45° FOV, 2352 by 1568 pixels — 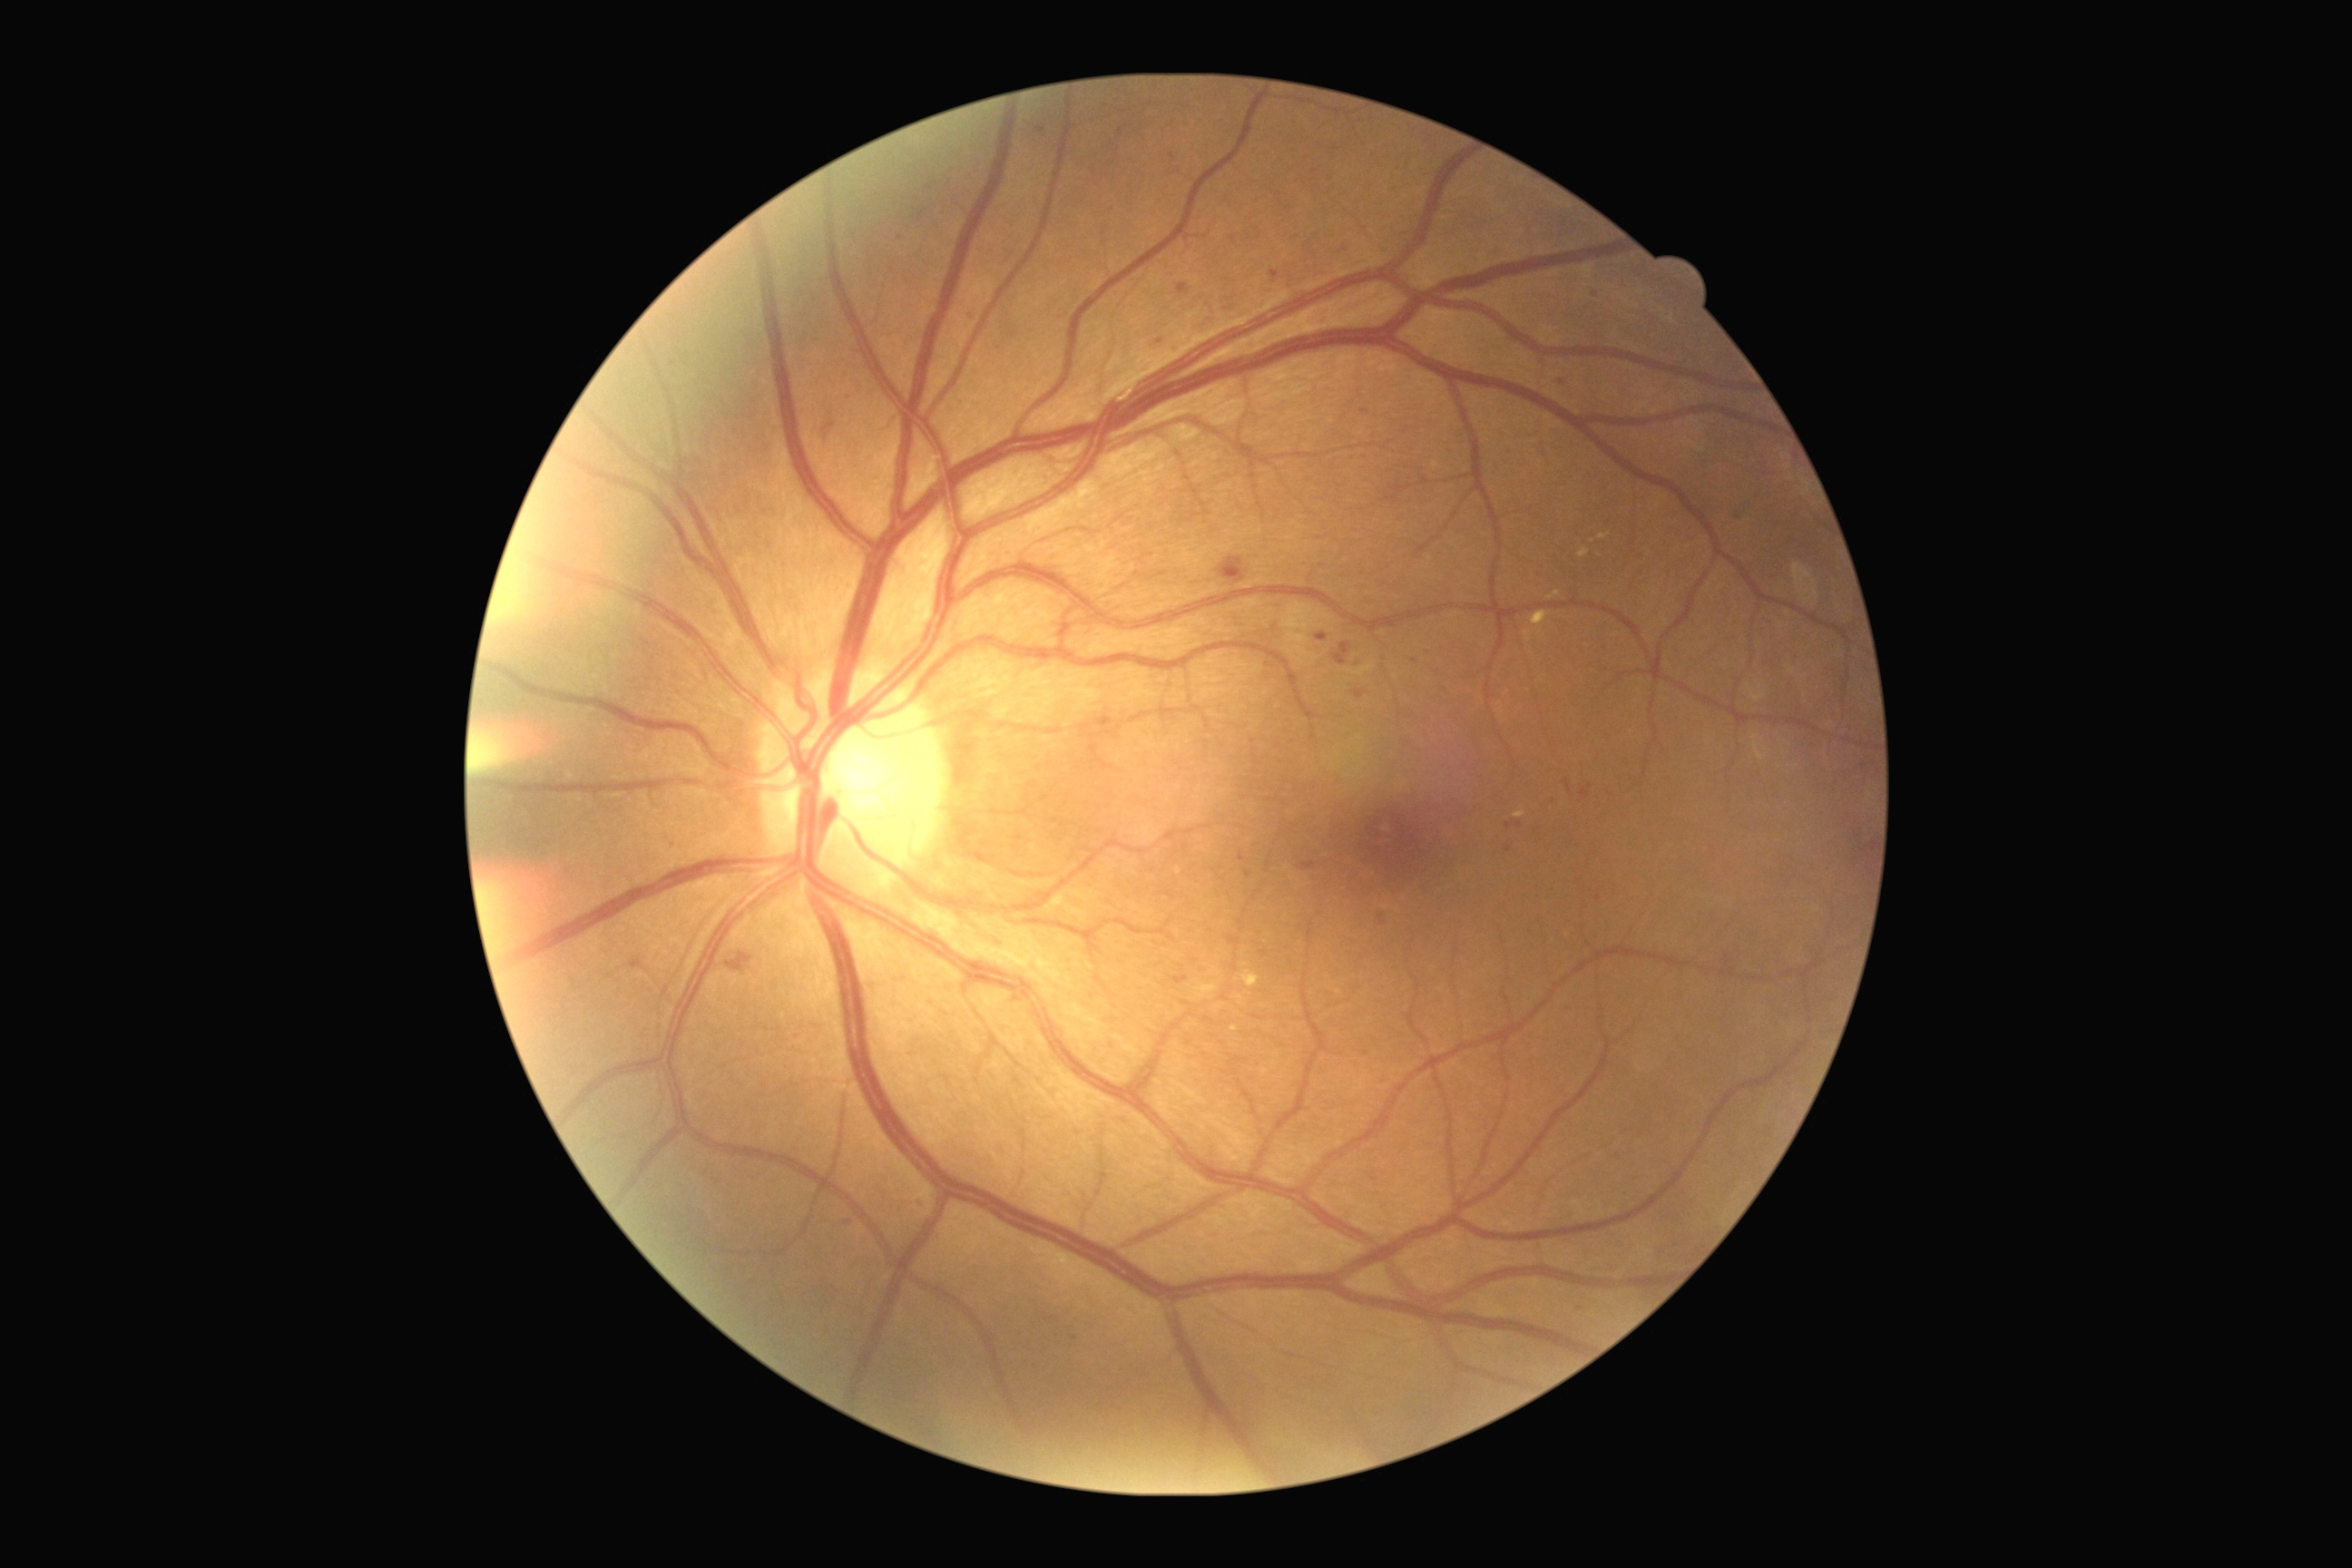

<lesions partial="true">
  <dr_grade>2</dr_grade>
  <ma partial="true">[1175,977,1188,985] | [631,957,642,970] | [1271,271,1279,279] | [1300,861,1317,872]</ma>
  <ma_small>[x=1162, y=574] | [x=922, y=214] | [x=1599, y=899] | [x=1508, y=826] | [x=1242, y=858] | [x=1248, y=876] | [x=1415, y=661] | [x=1040, y=130] | [x=1508, y=851] | [x=1641, y=558]</ma_small>
</lesions>